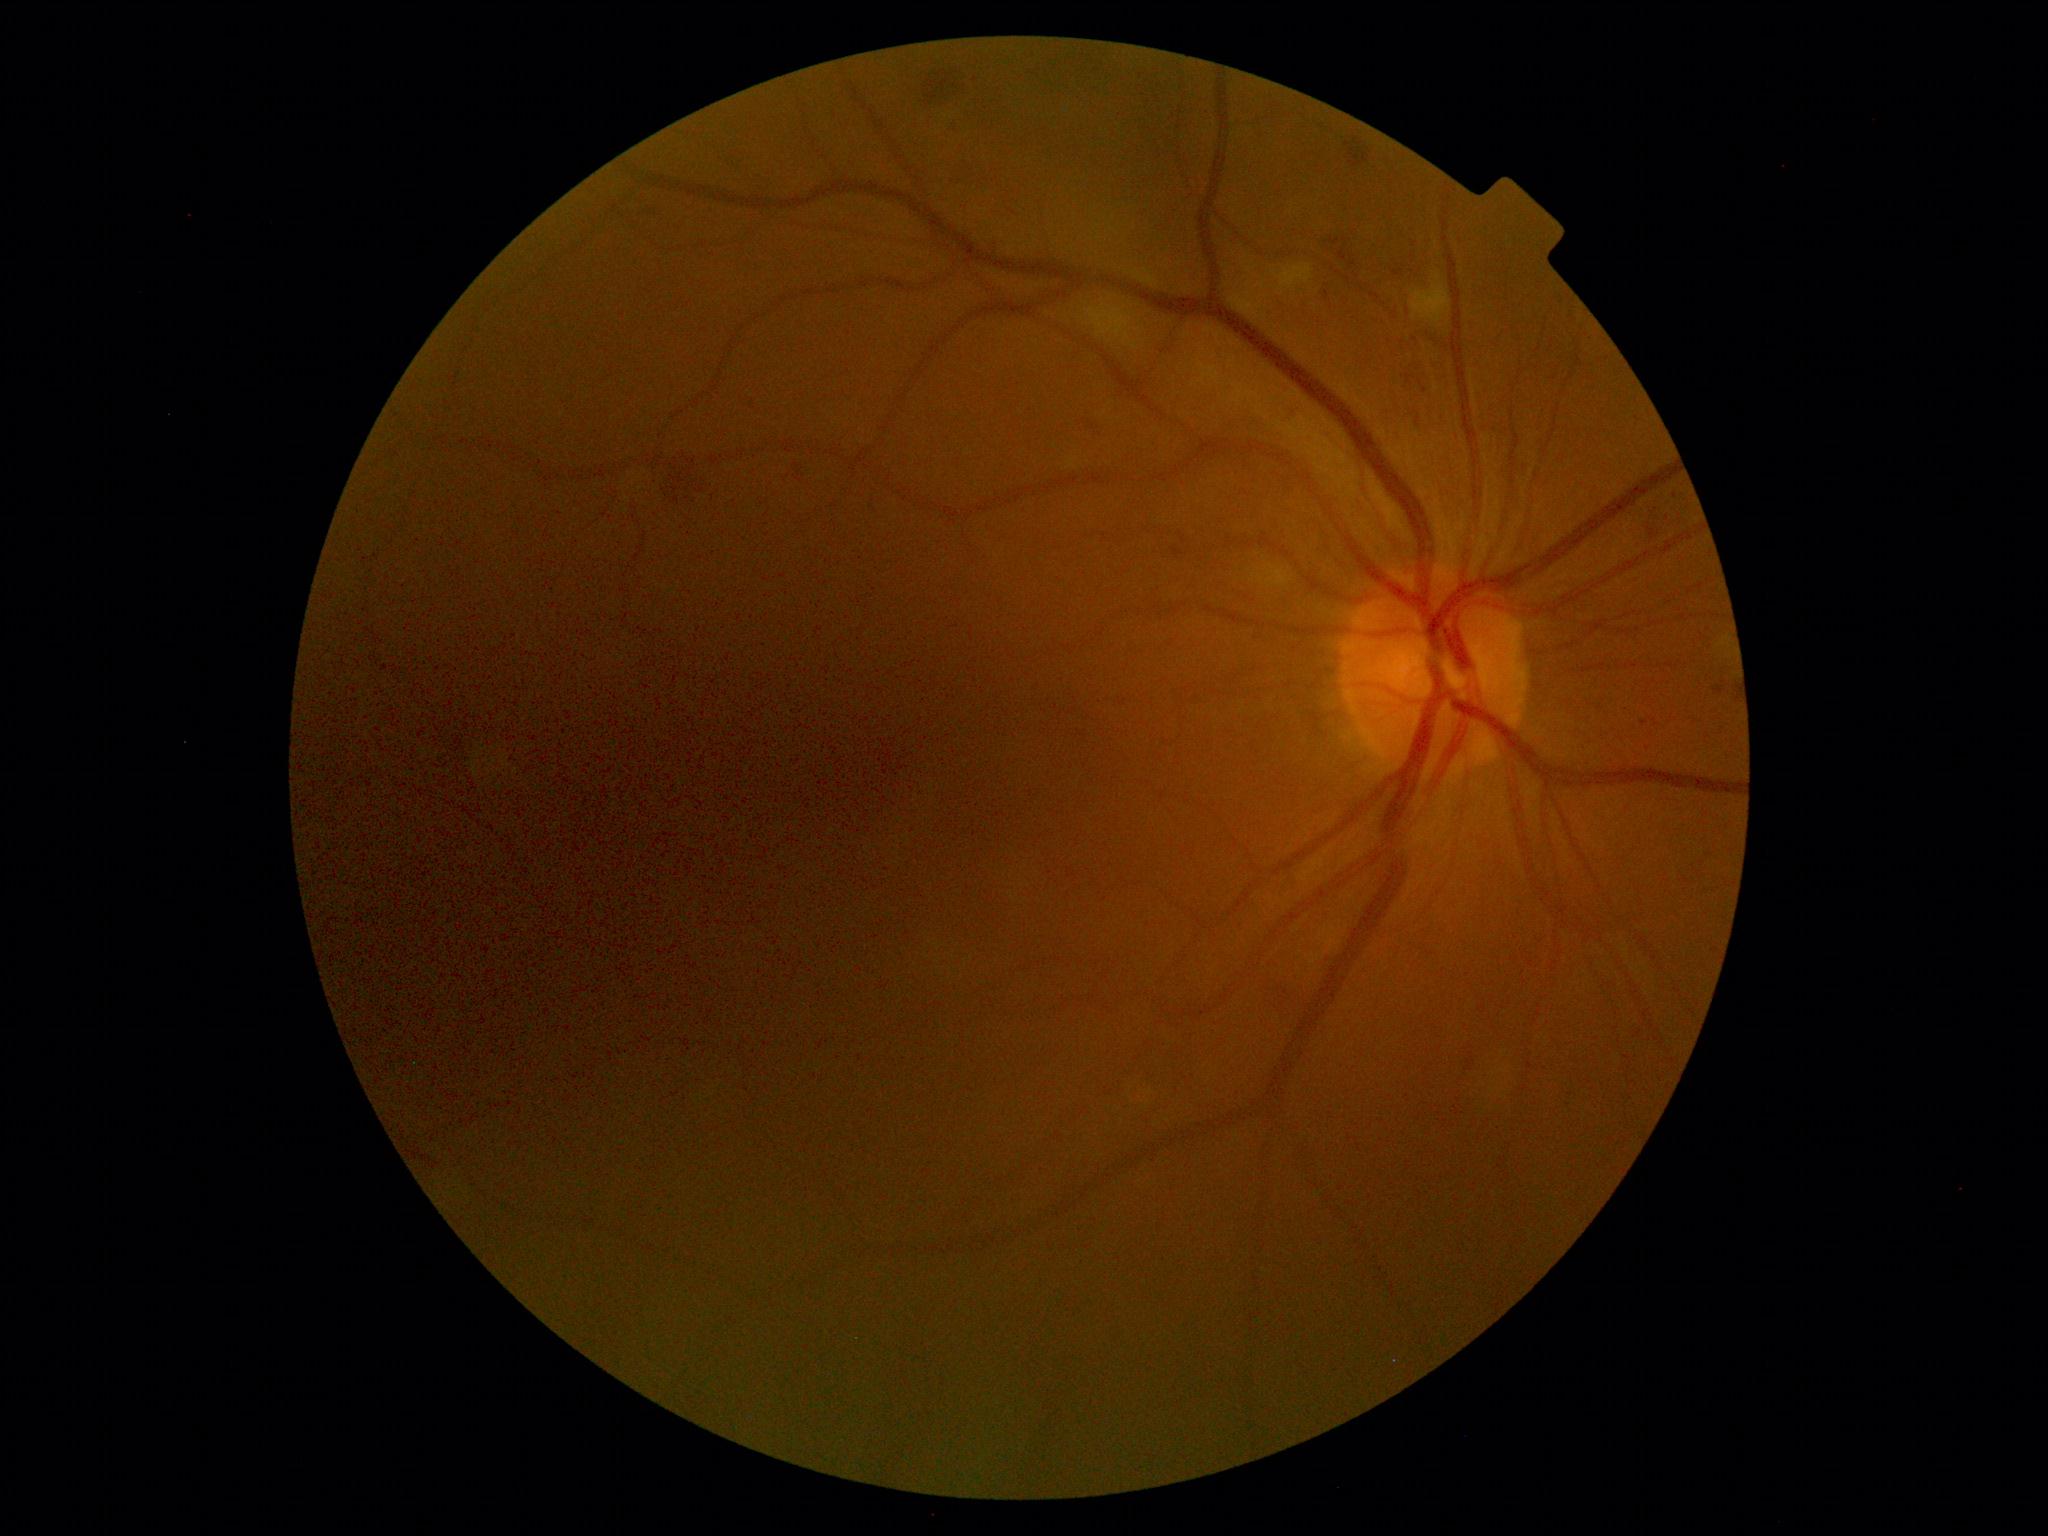 DR grade is 2.